CFP:
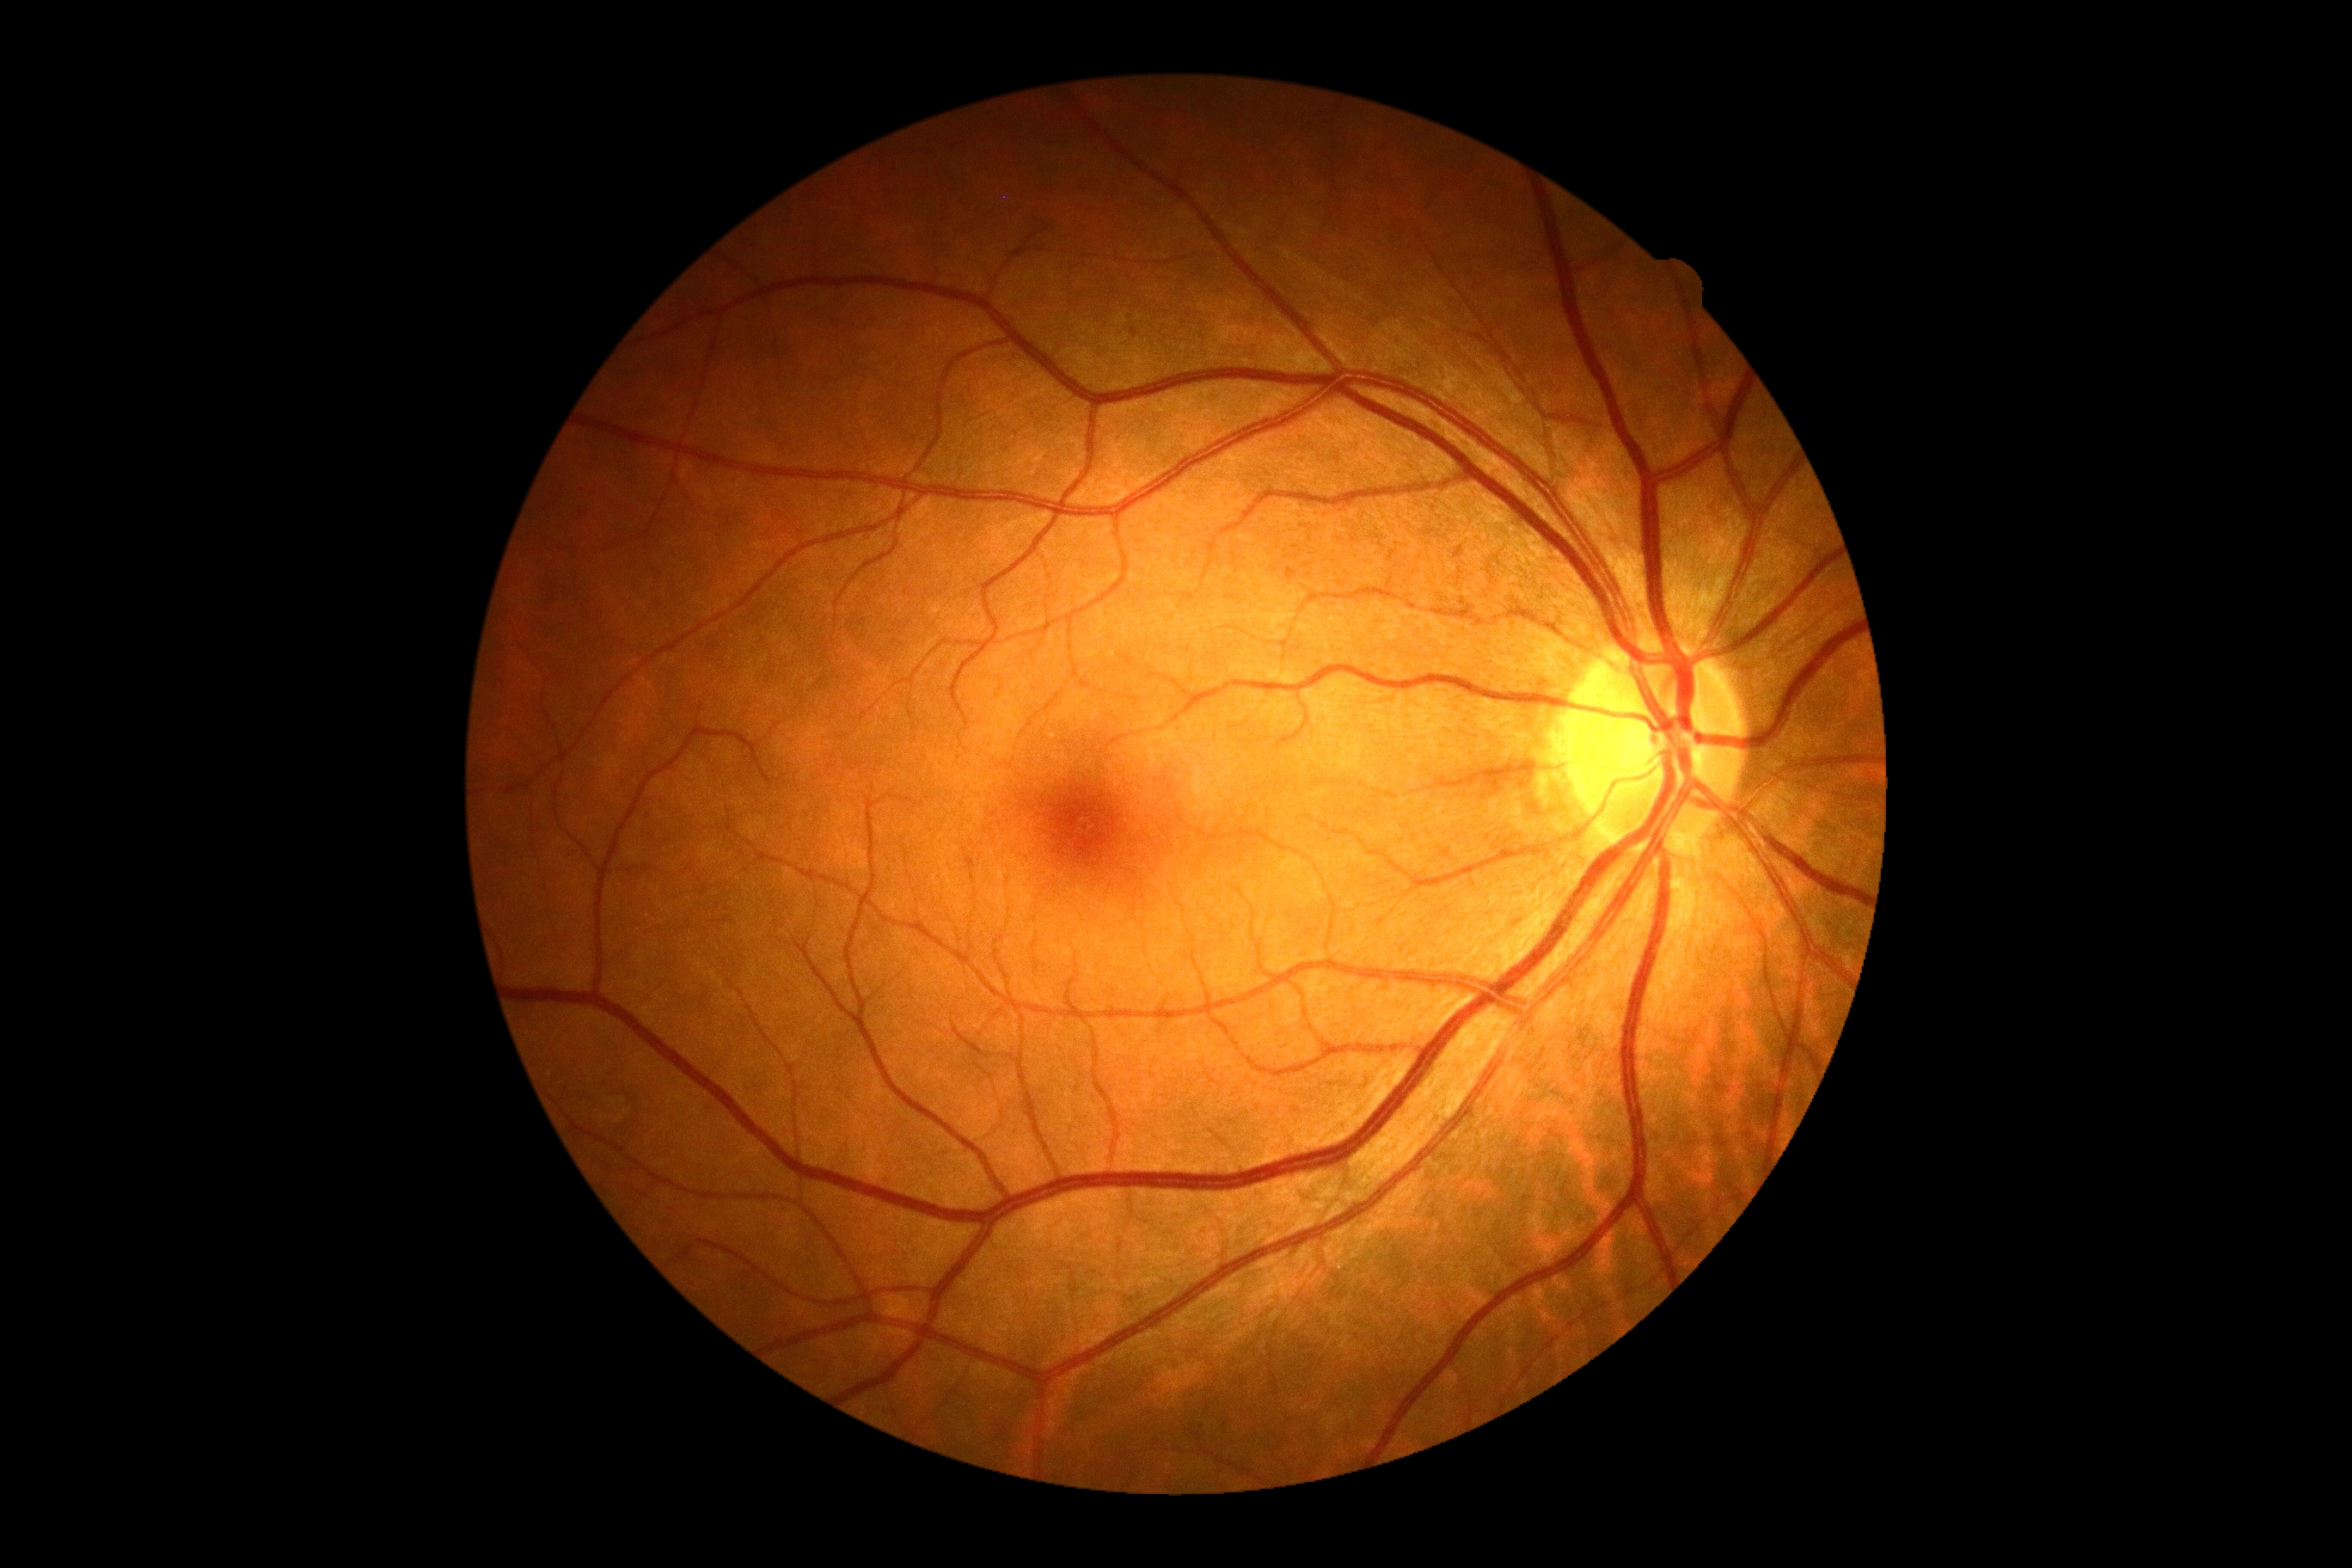 Diabetic retinopathy severity is grade 0.